Acquired with a NIDEK AFC-230 · no pharmacologic dilation · DR severity per modified Davis staging: 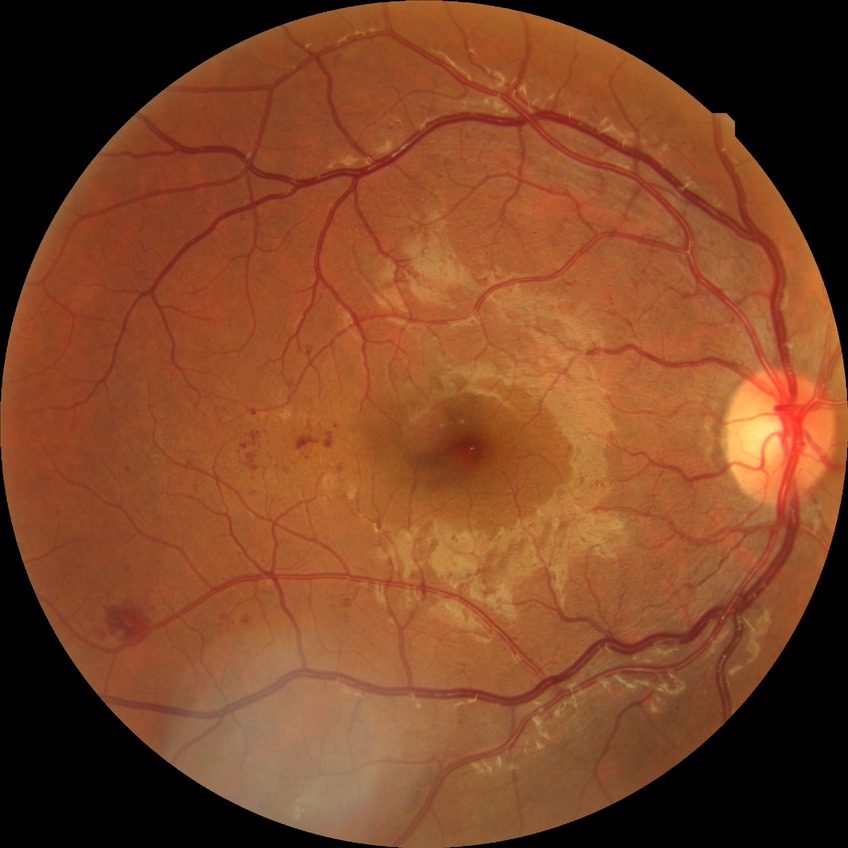
Diabetic retinopathy stage: pre-proliferative diabetic retinopathy.